Color fundus photograph: 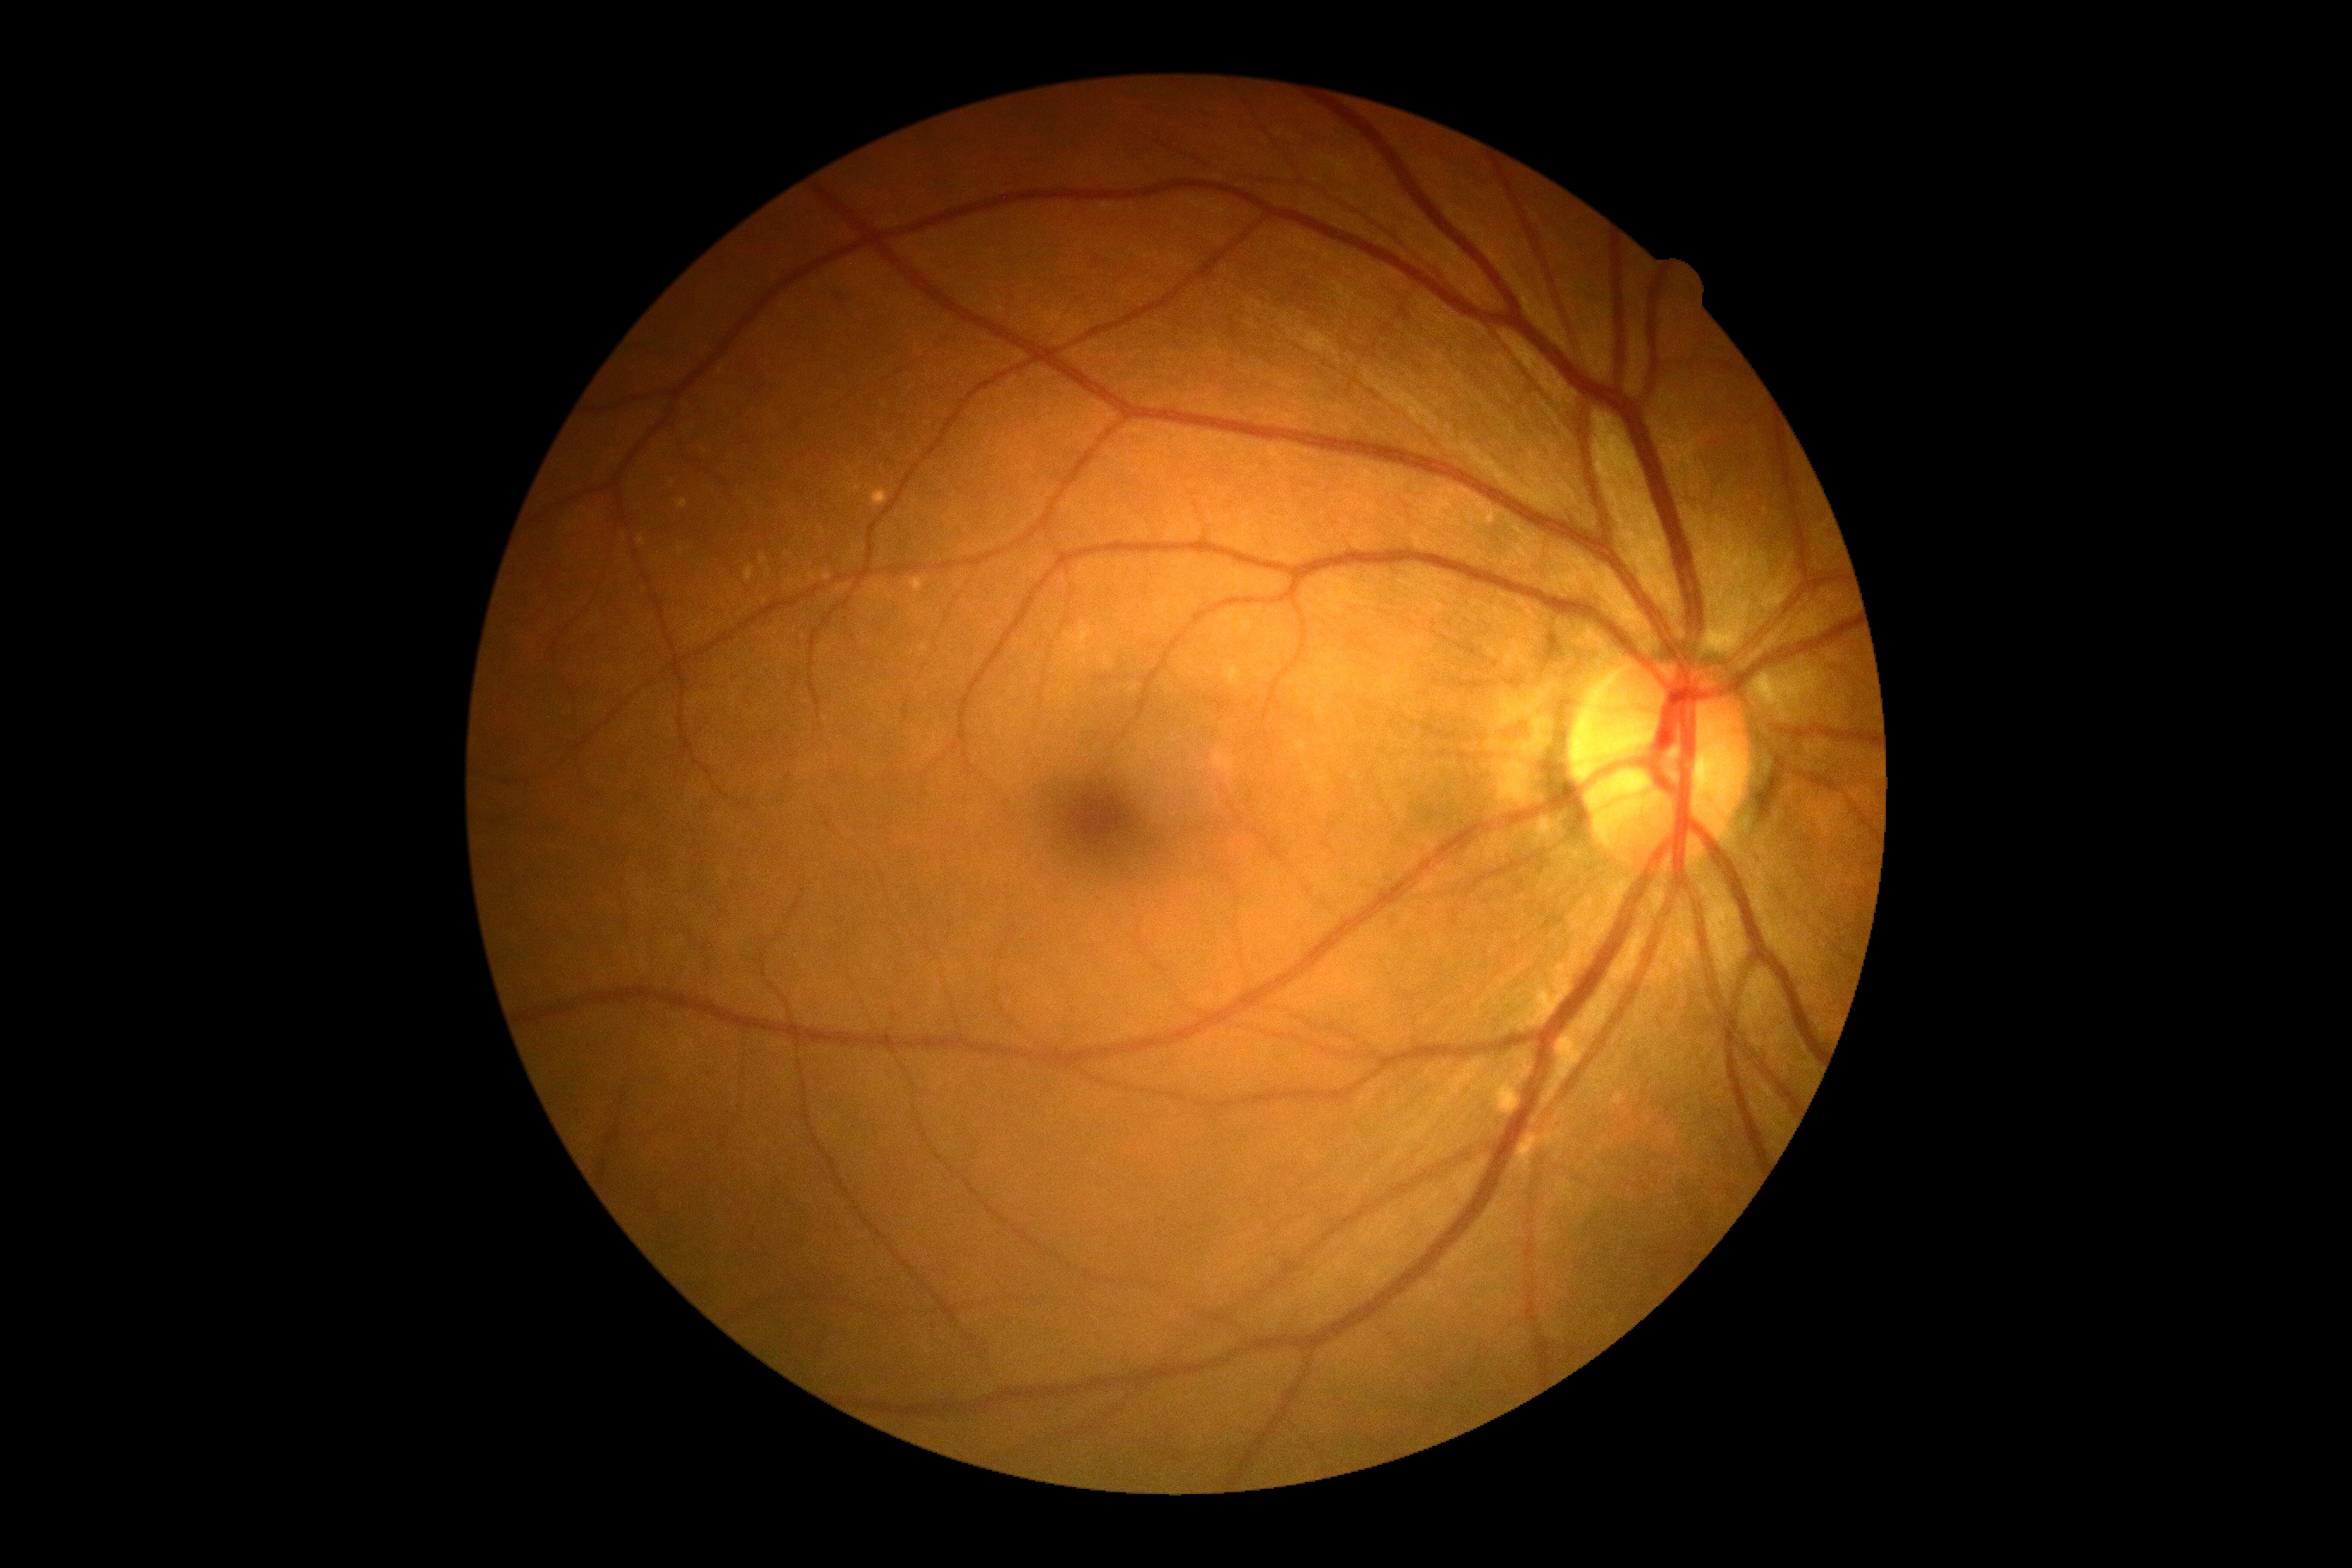
DR impression: no DR findings
DR: grade 0